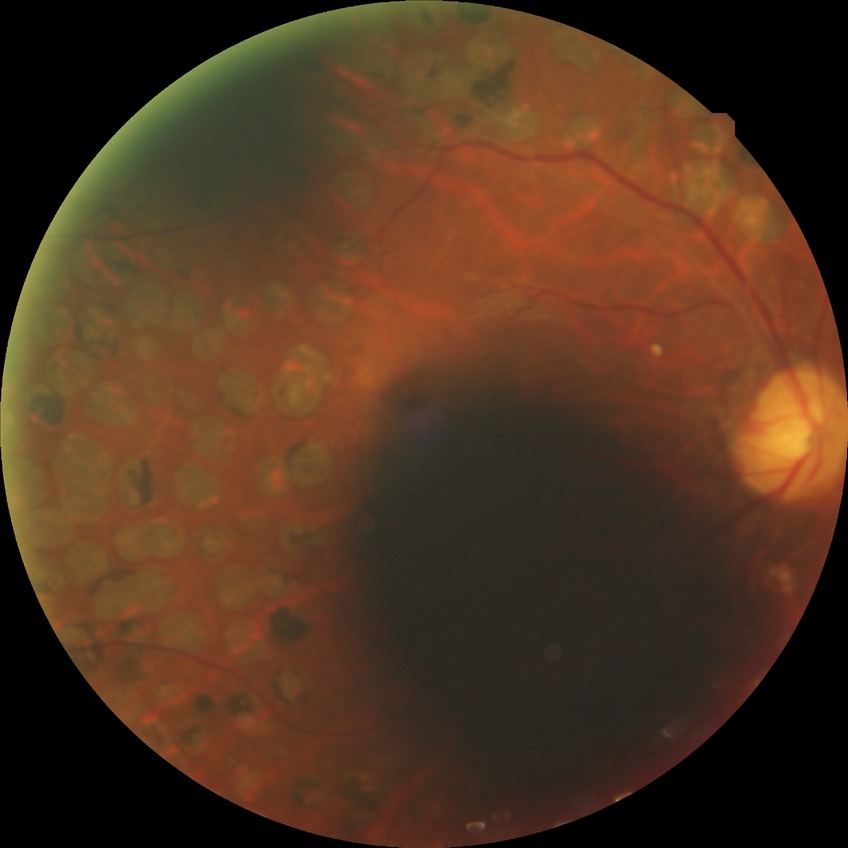
Assessment:
– diabetic retinopathy (DR): PDR (proliferative diabetic retinopathy)